CFP; image size 848x848; acquired with a NIDEK AFC-230
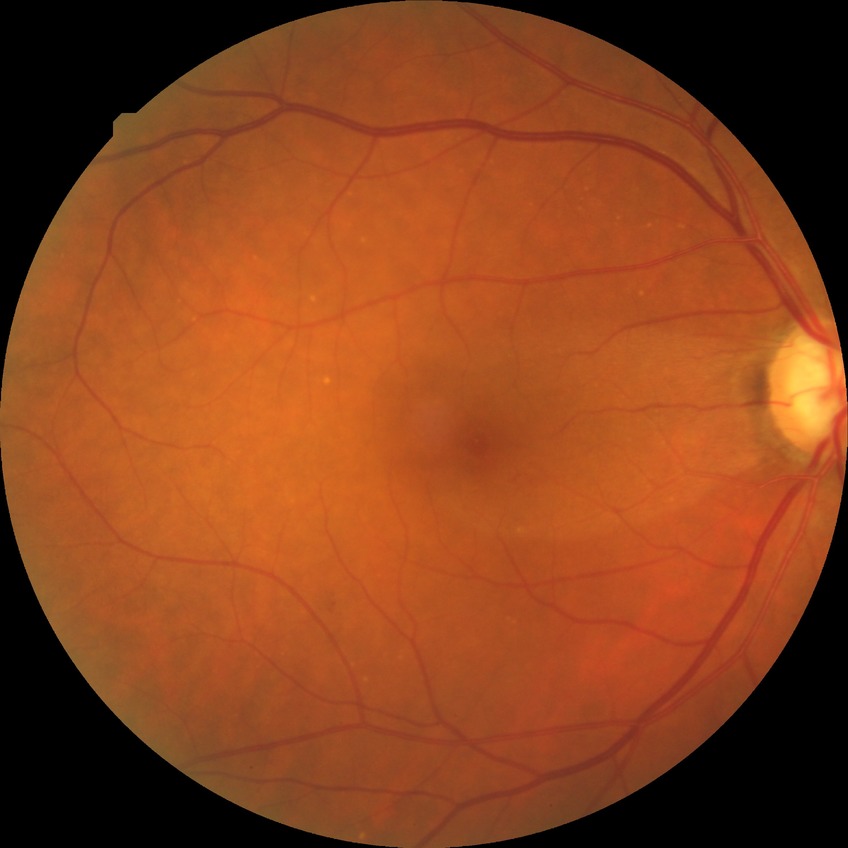
{"davis_grade": "simple diabetic retinopathy", "proliferative_class": "non-proliferative diabetic retinopathy"}